FOV: 45 degrees · fundus photo · 1470x1137px — 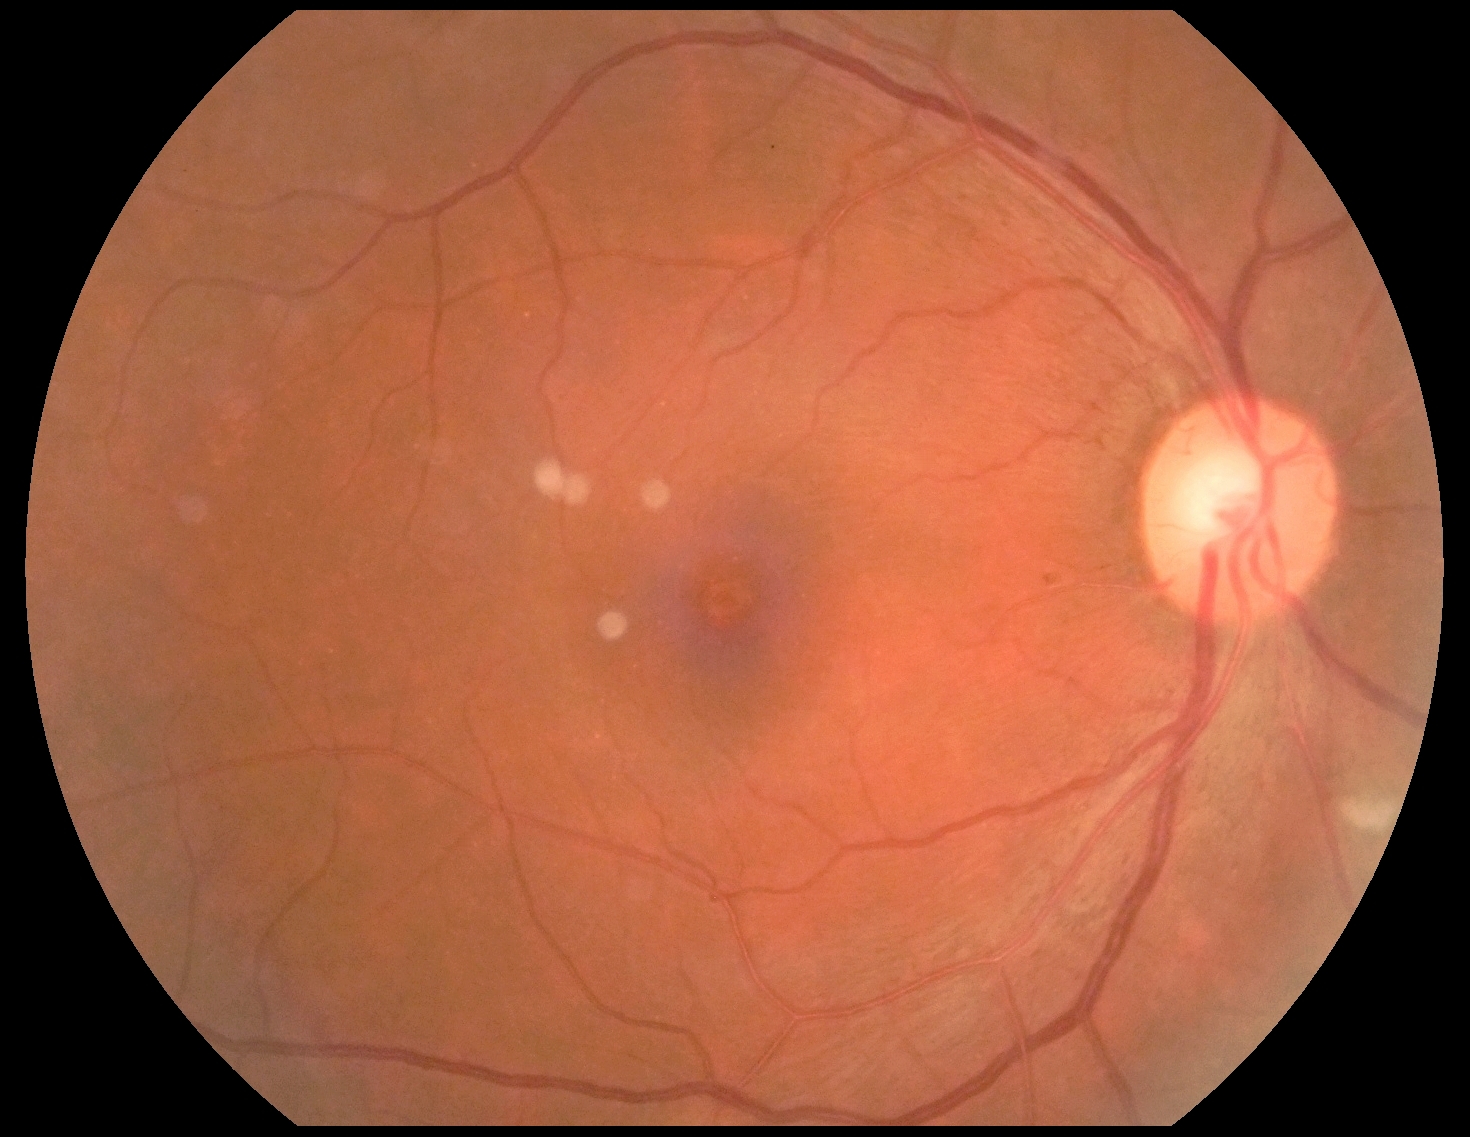

DR class: non-proliferative diabetic retinopathy.
DR grade is 2/4.